CFP. 45-degree field of view
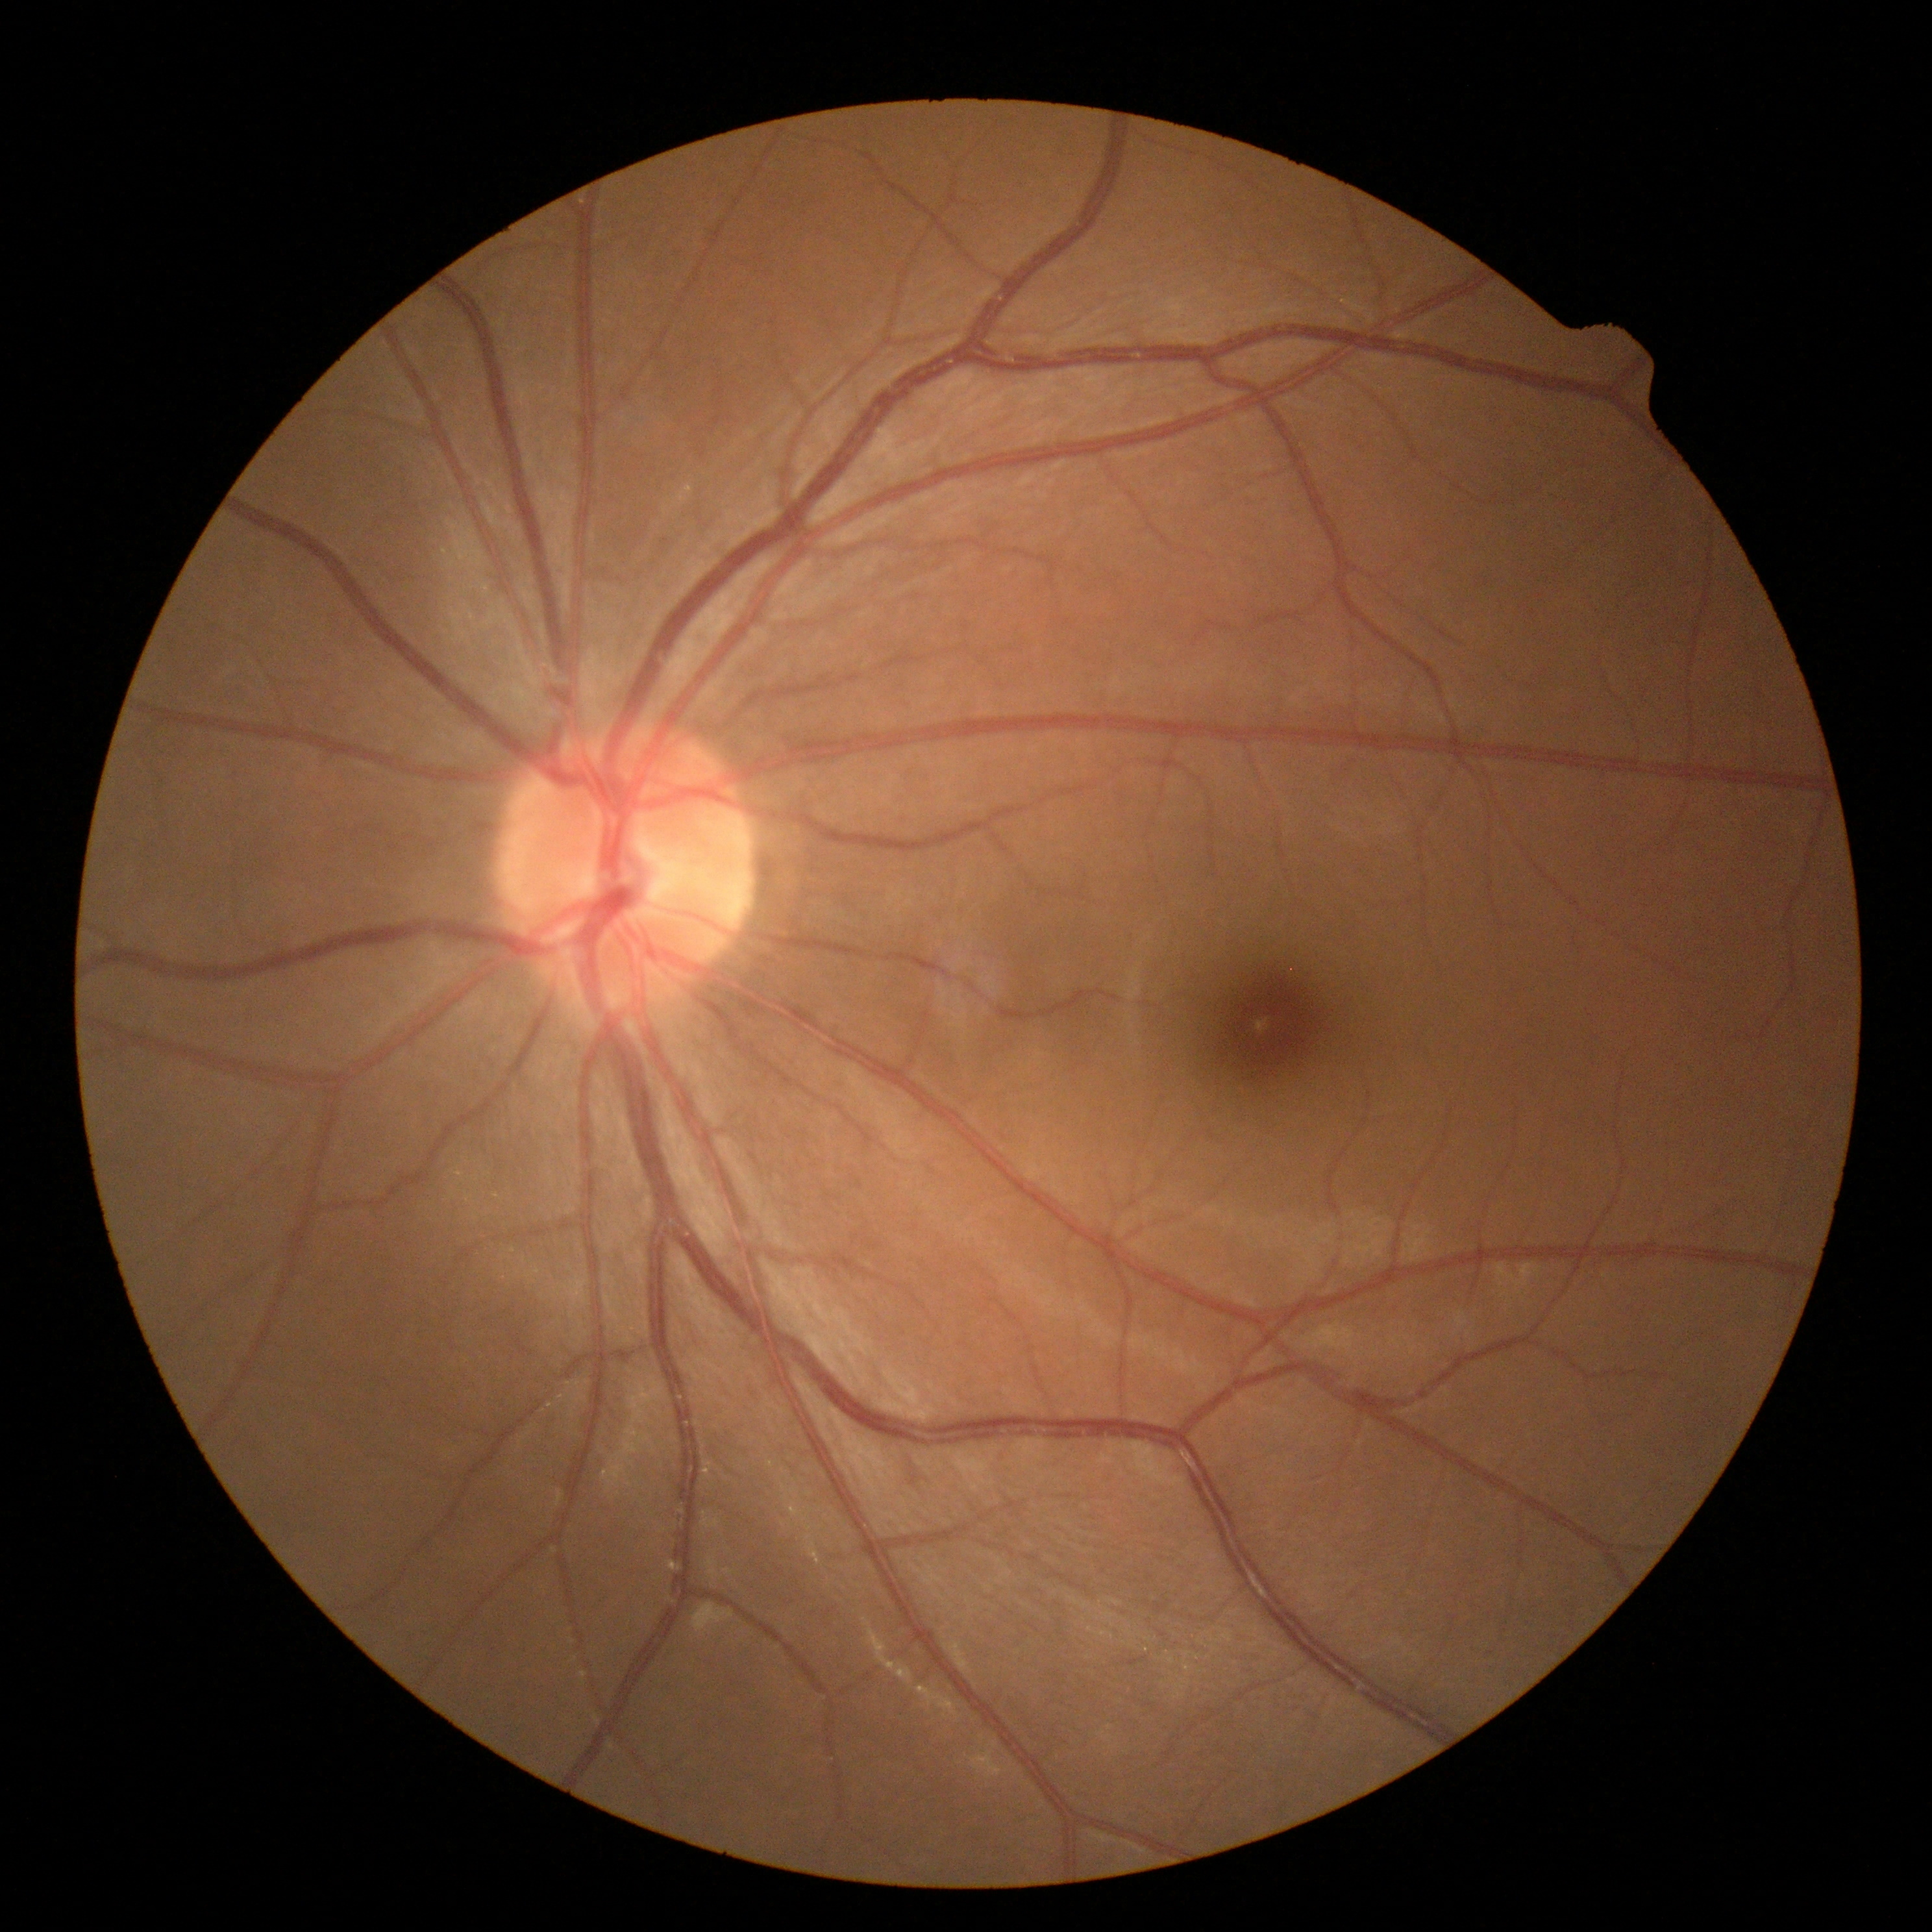
Diabetic retinopathy: 0/4.
No apparent diabetic retinopathy.